CFP; Remidio Fundus on Phone (FOP) camera; 1659x2212:
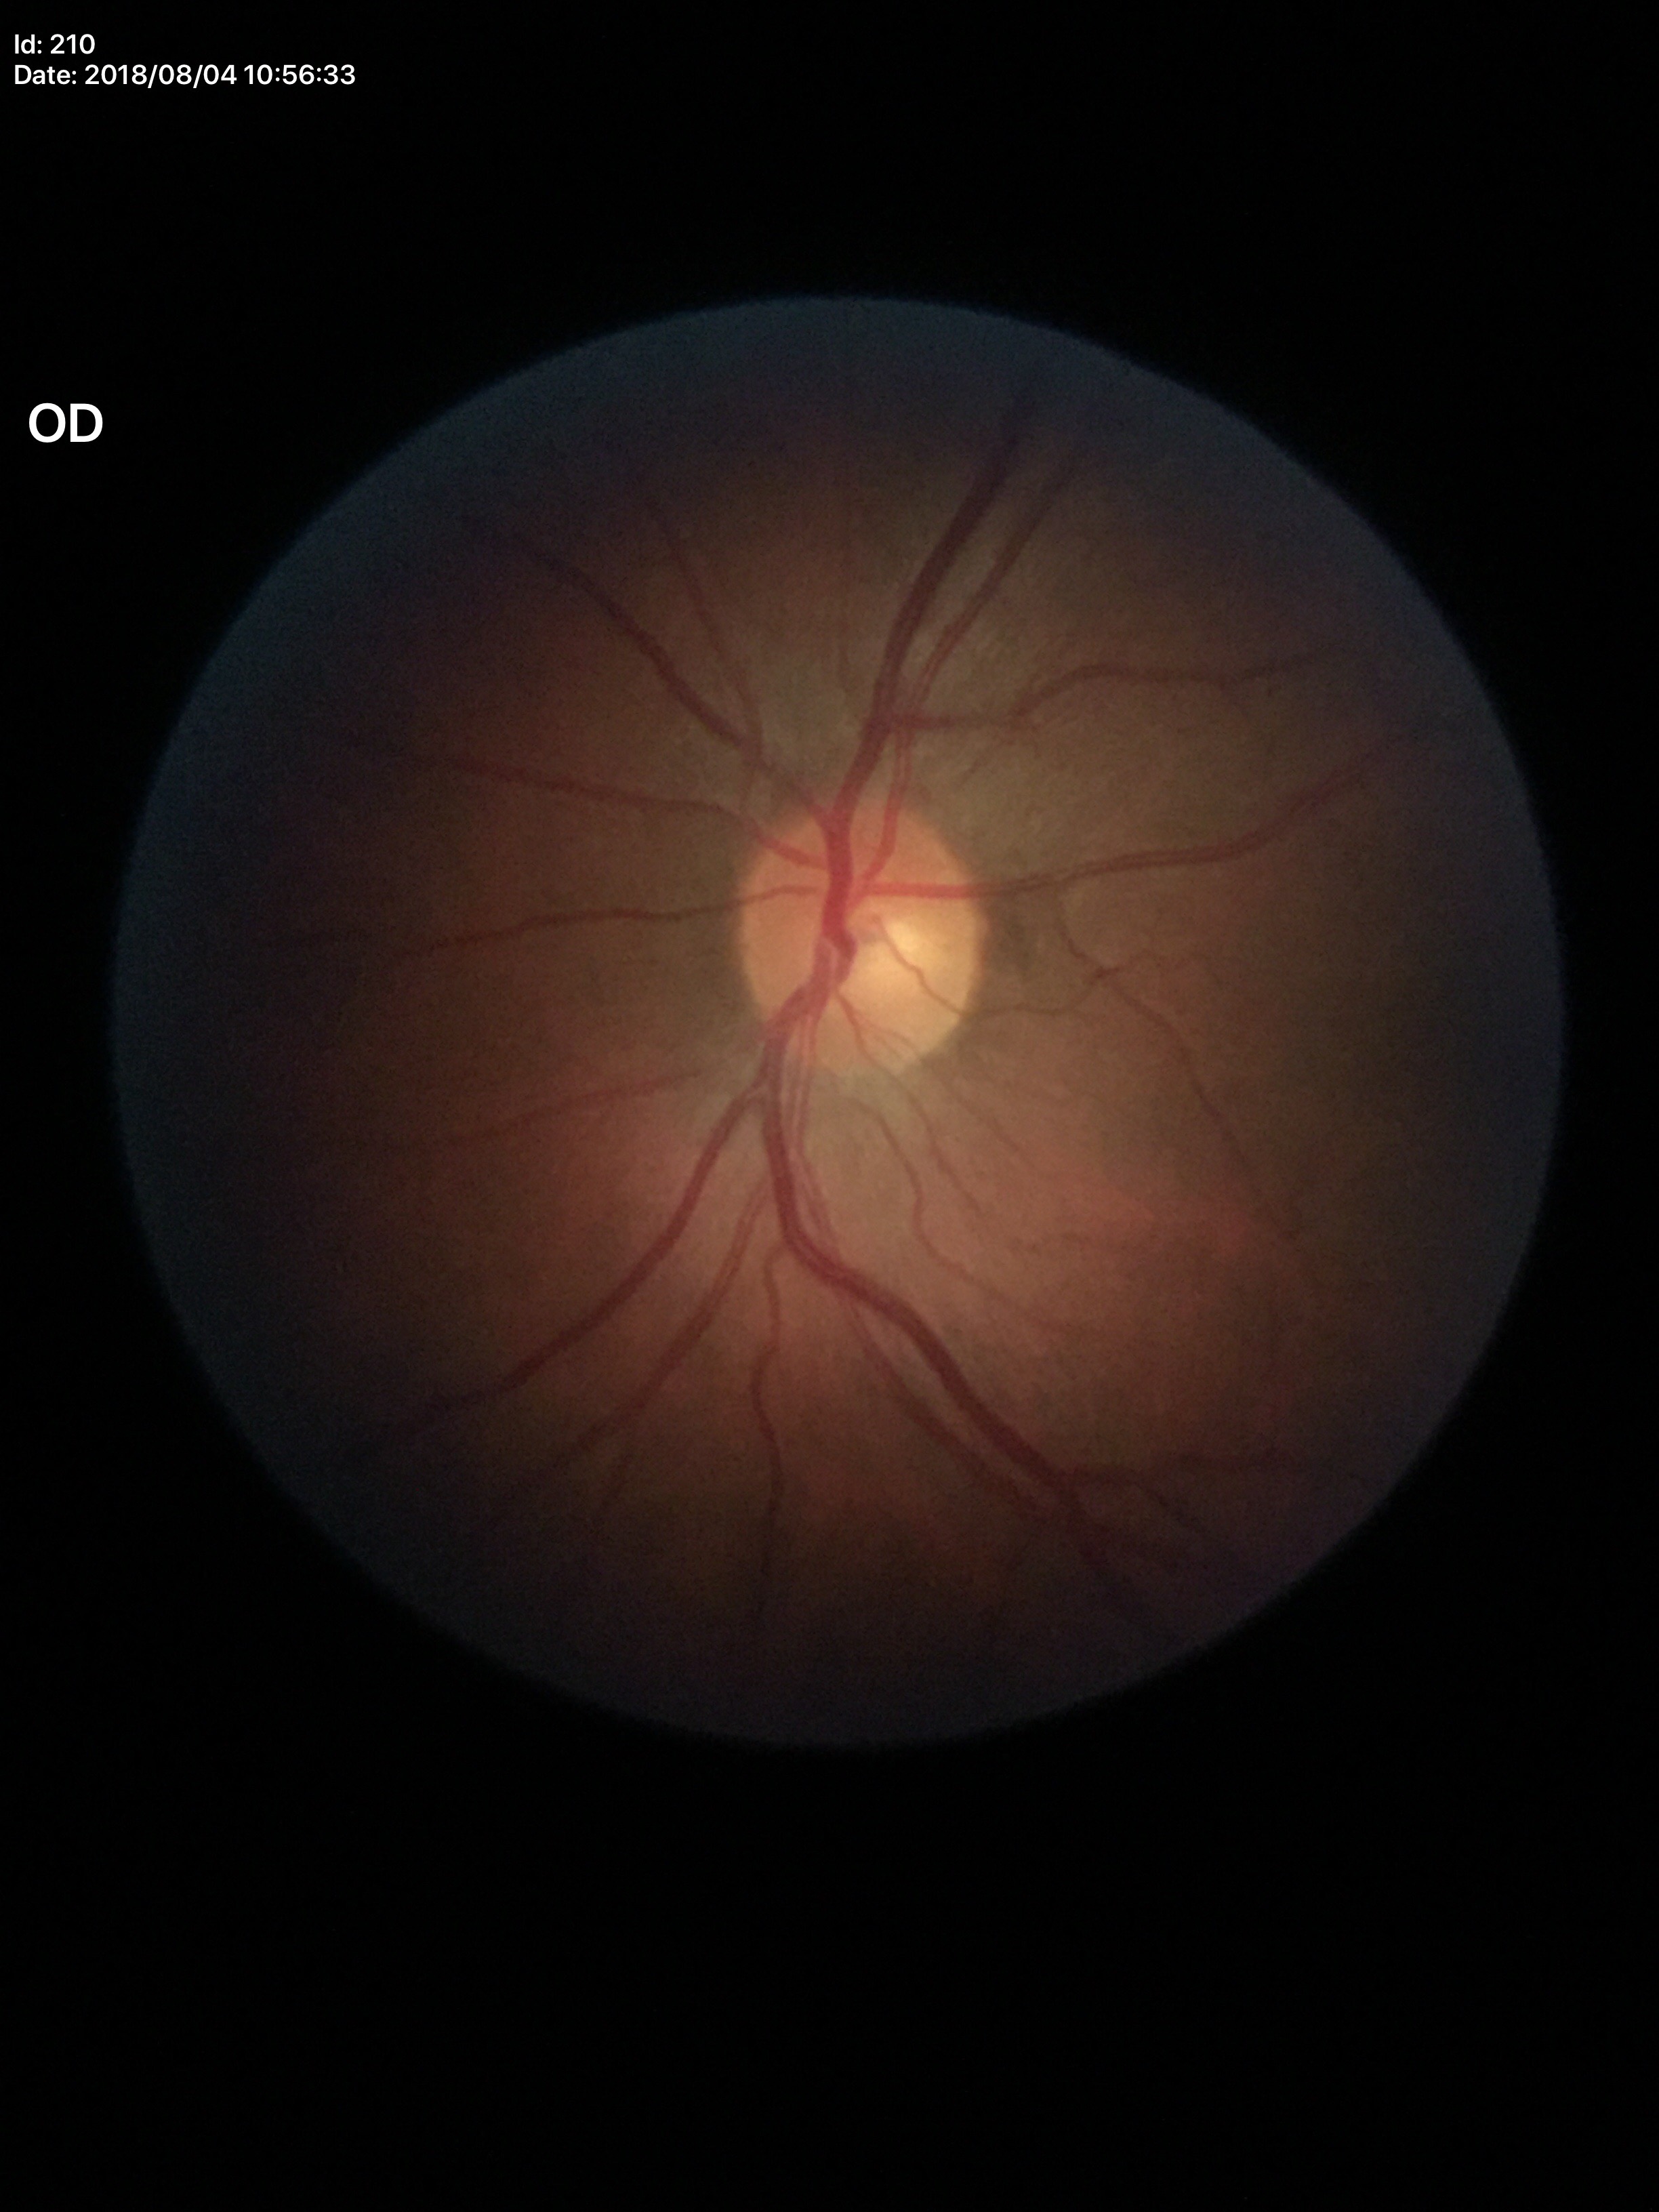
HCDR: 0.56 | VCDR: 0.49 | Glaucoma screening impression: not suspect.